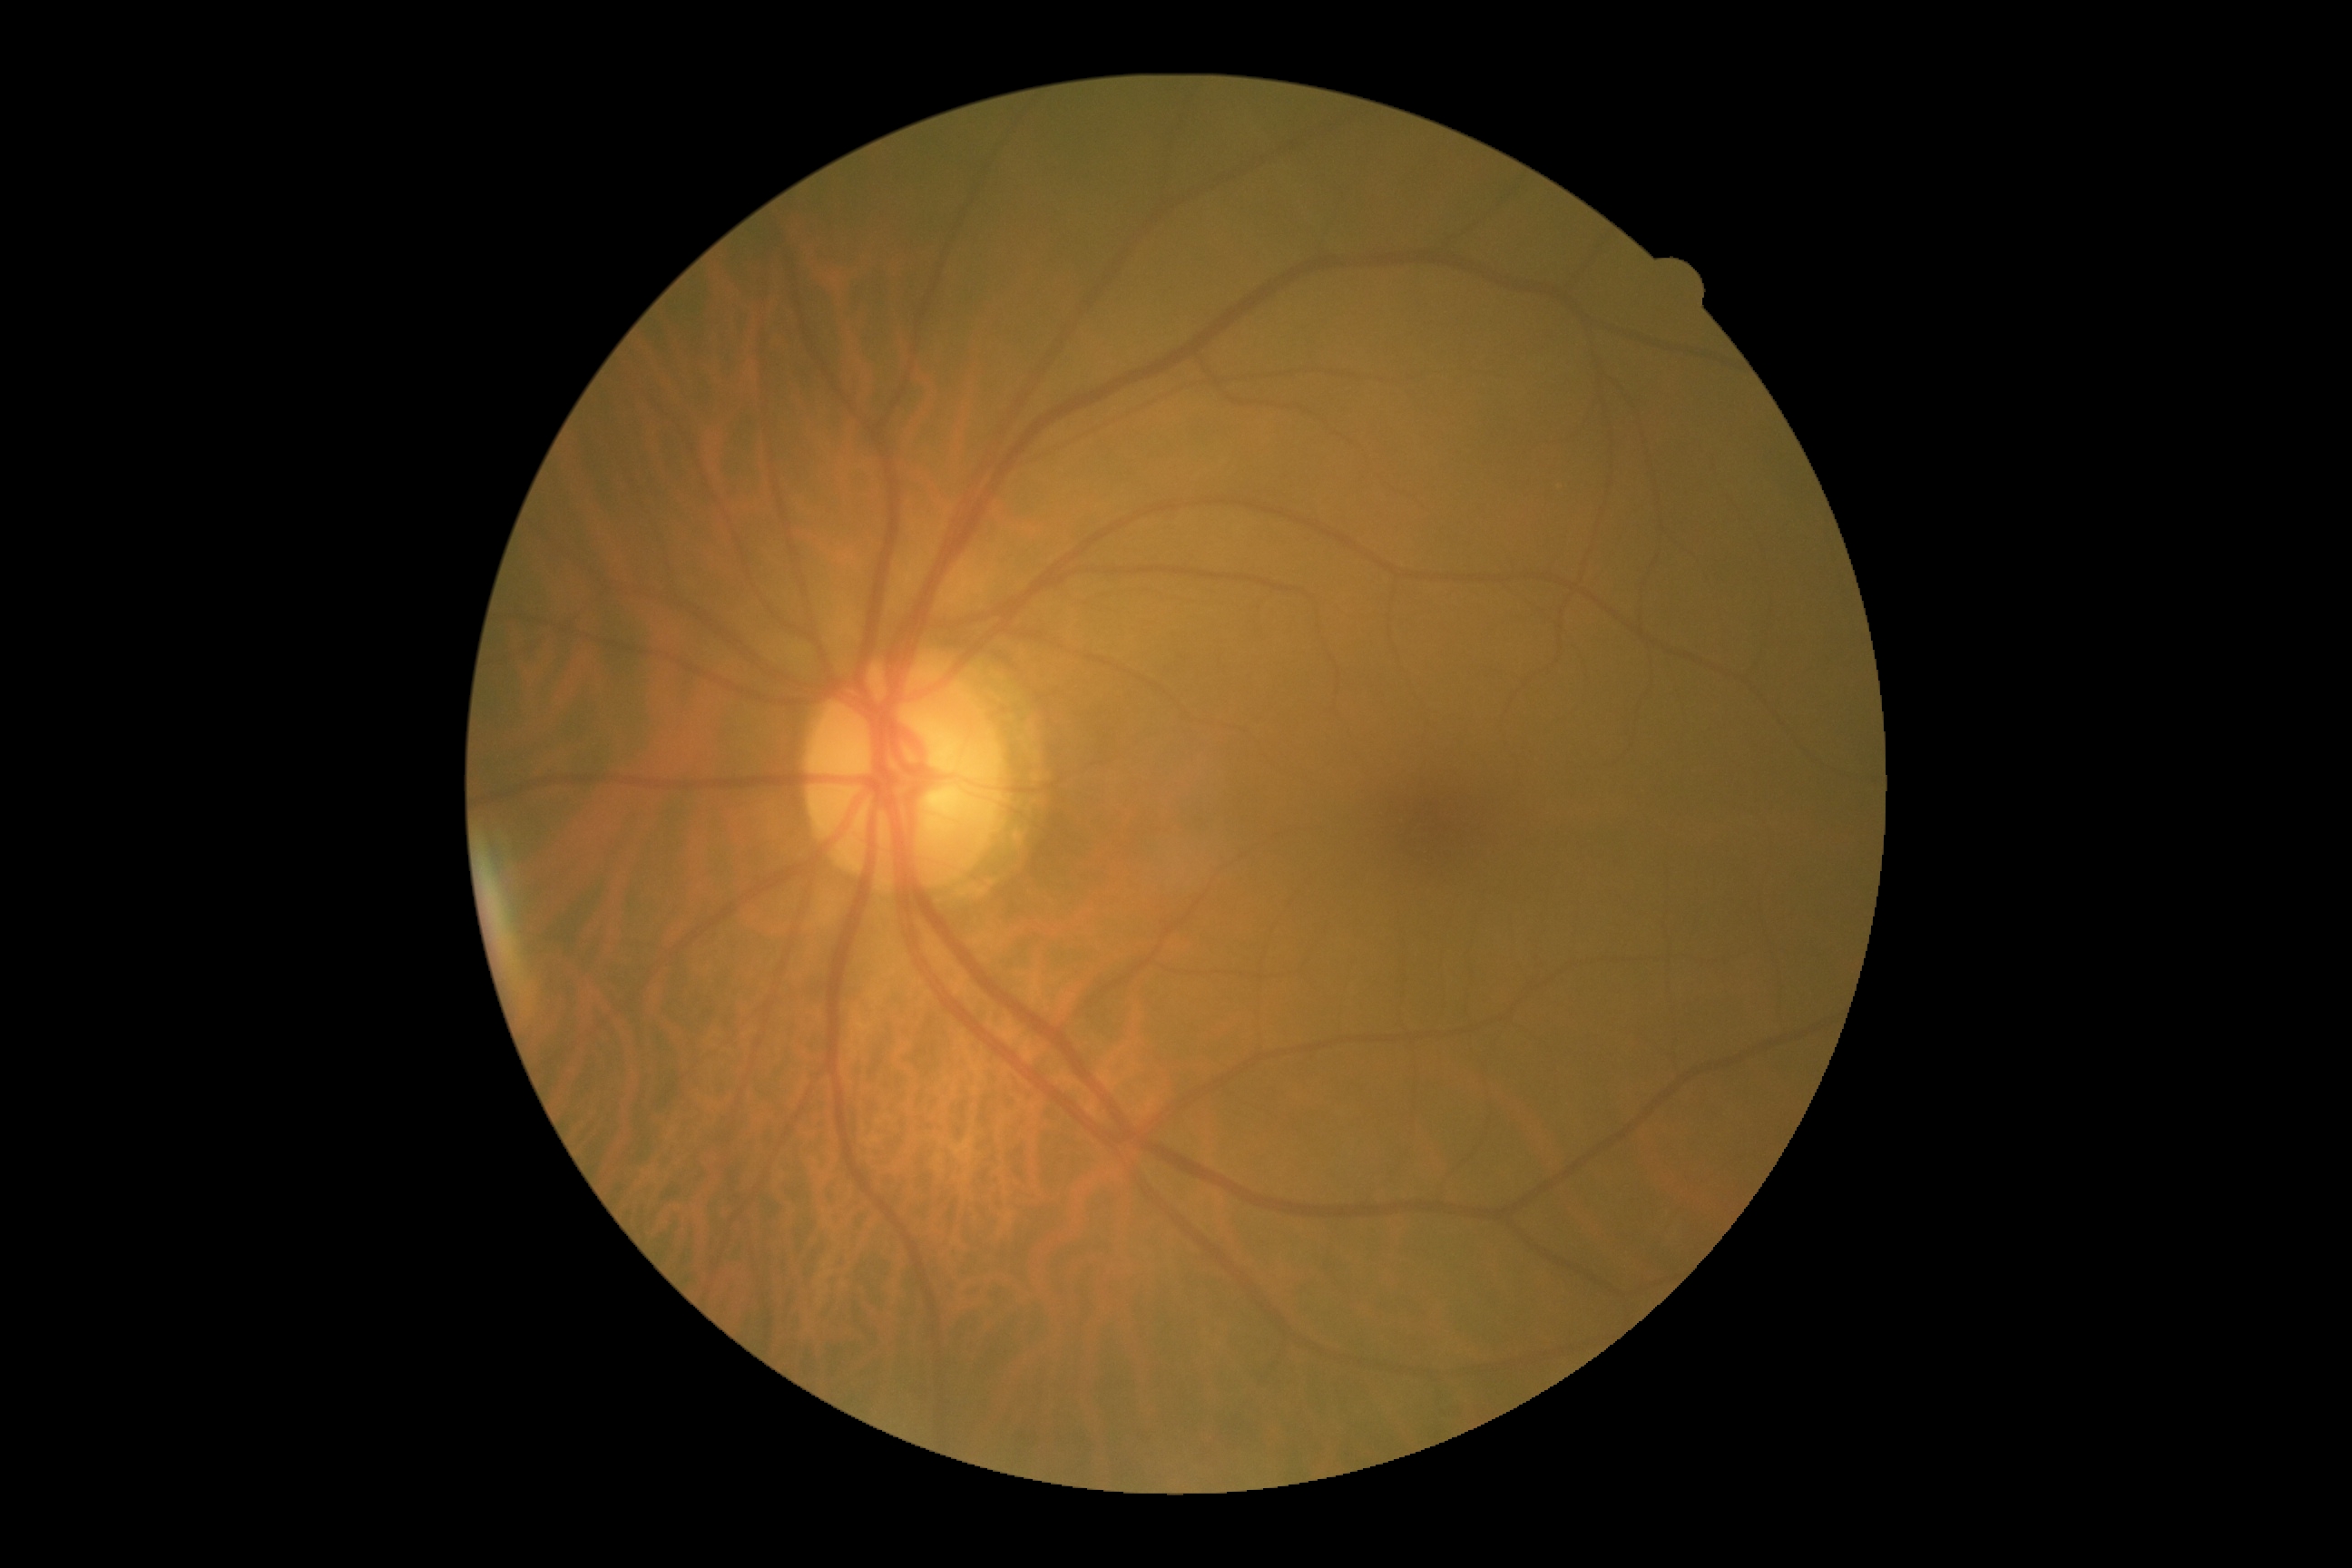

diabetic retinopathy (DR)=0/4.